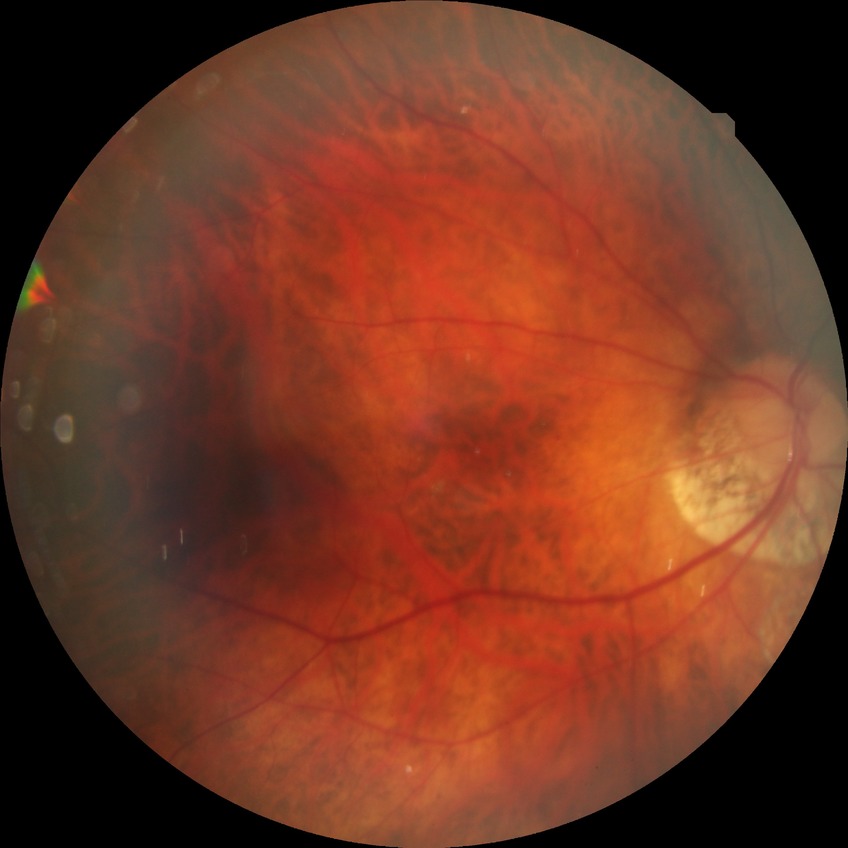

Annotations:
• DR severity — NDR